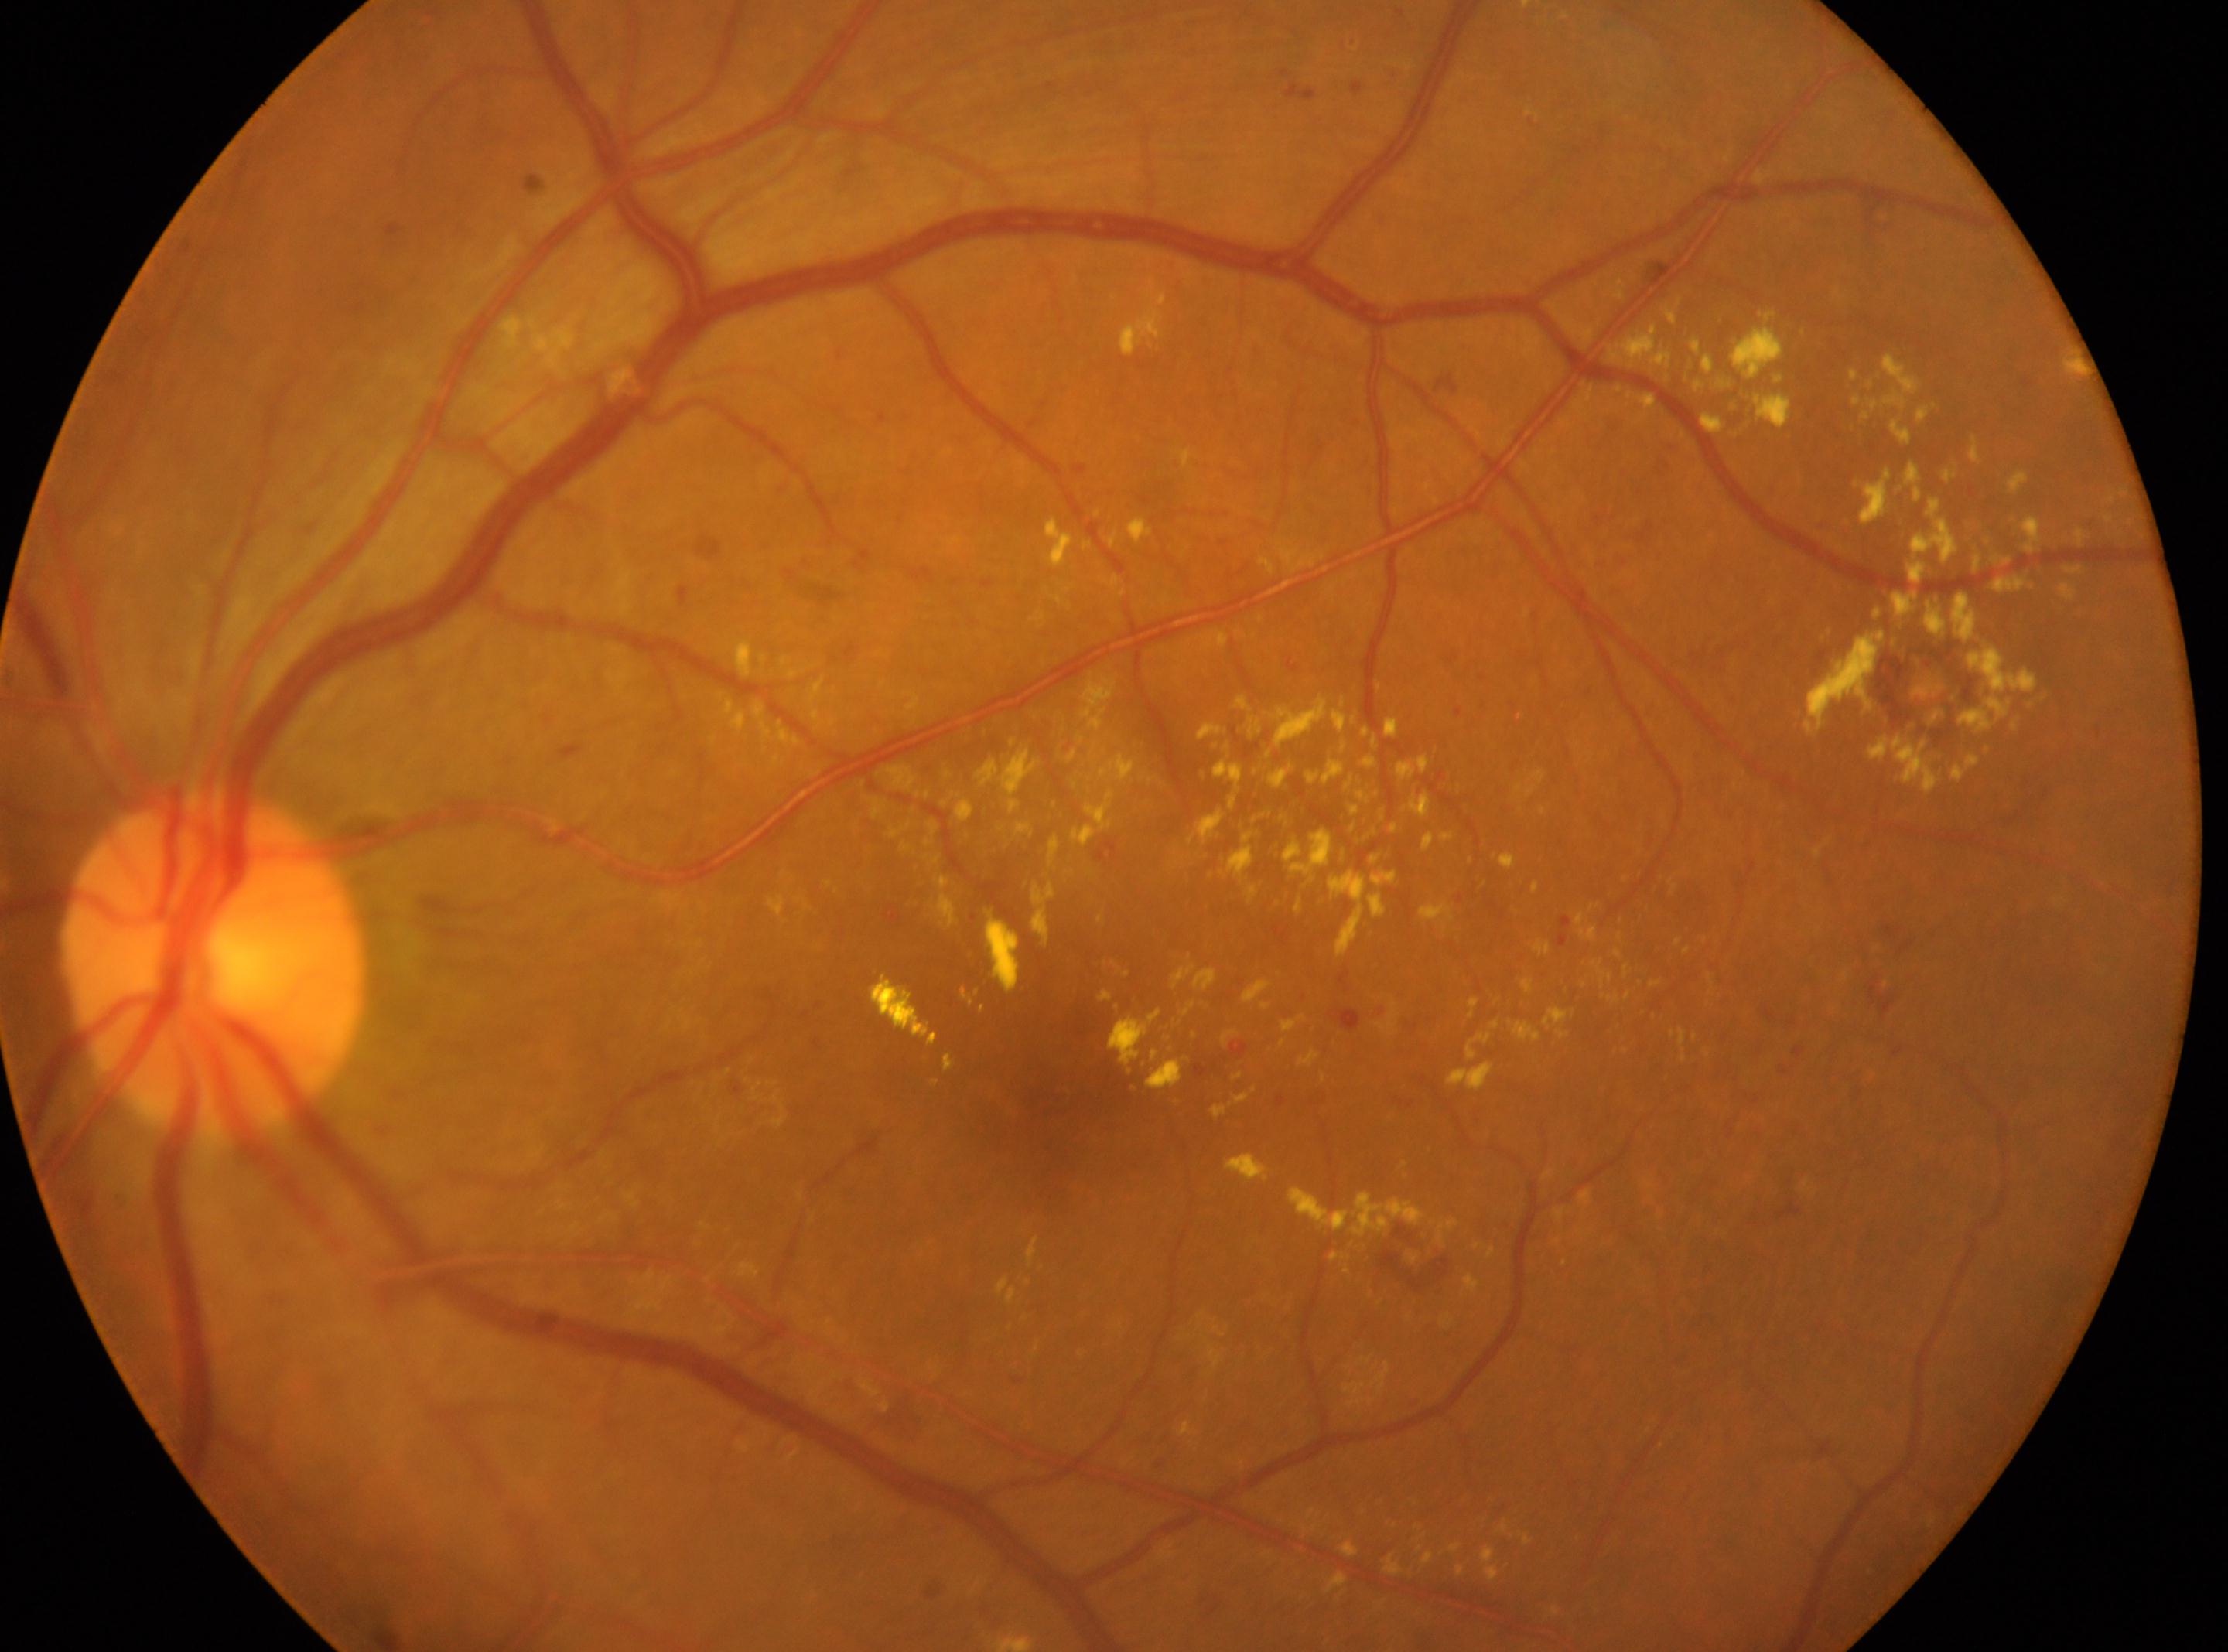

Diabetic retinopathy (DR) is grade 2 — more than just microaneurysms but less than severe NPDR.
This is the left eye.
The fovea center is at (1051,1112).
ONH: (213,964).
Disease class: non-proliferative diabetic retinopathy.